Topcon TRC-NW8: 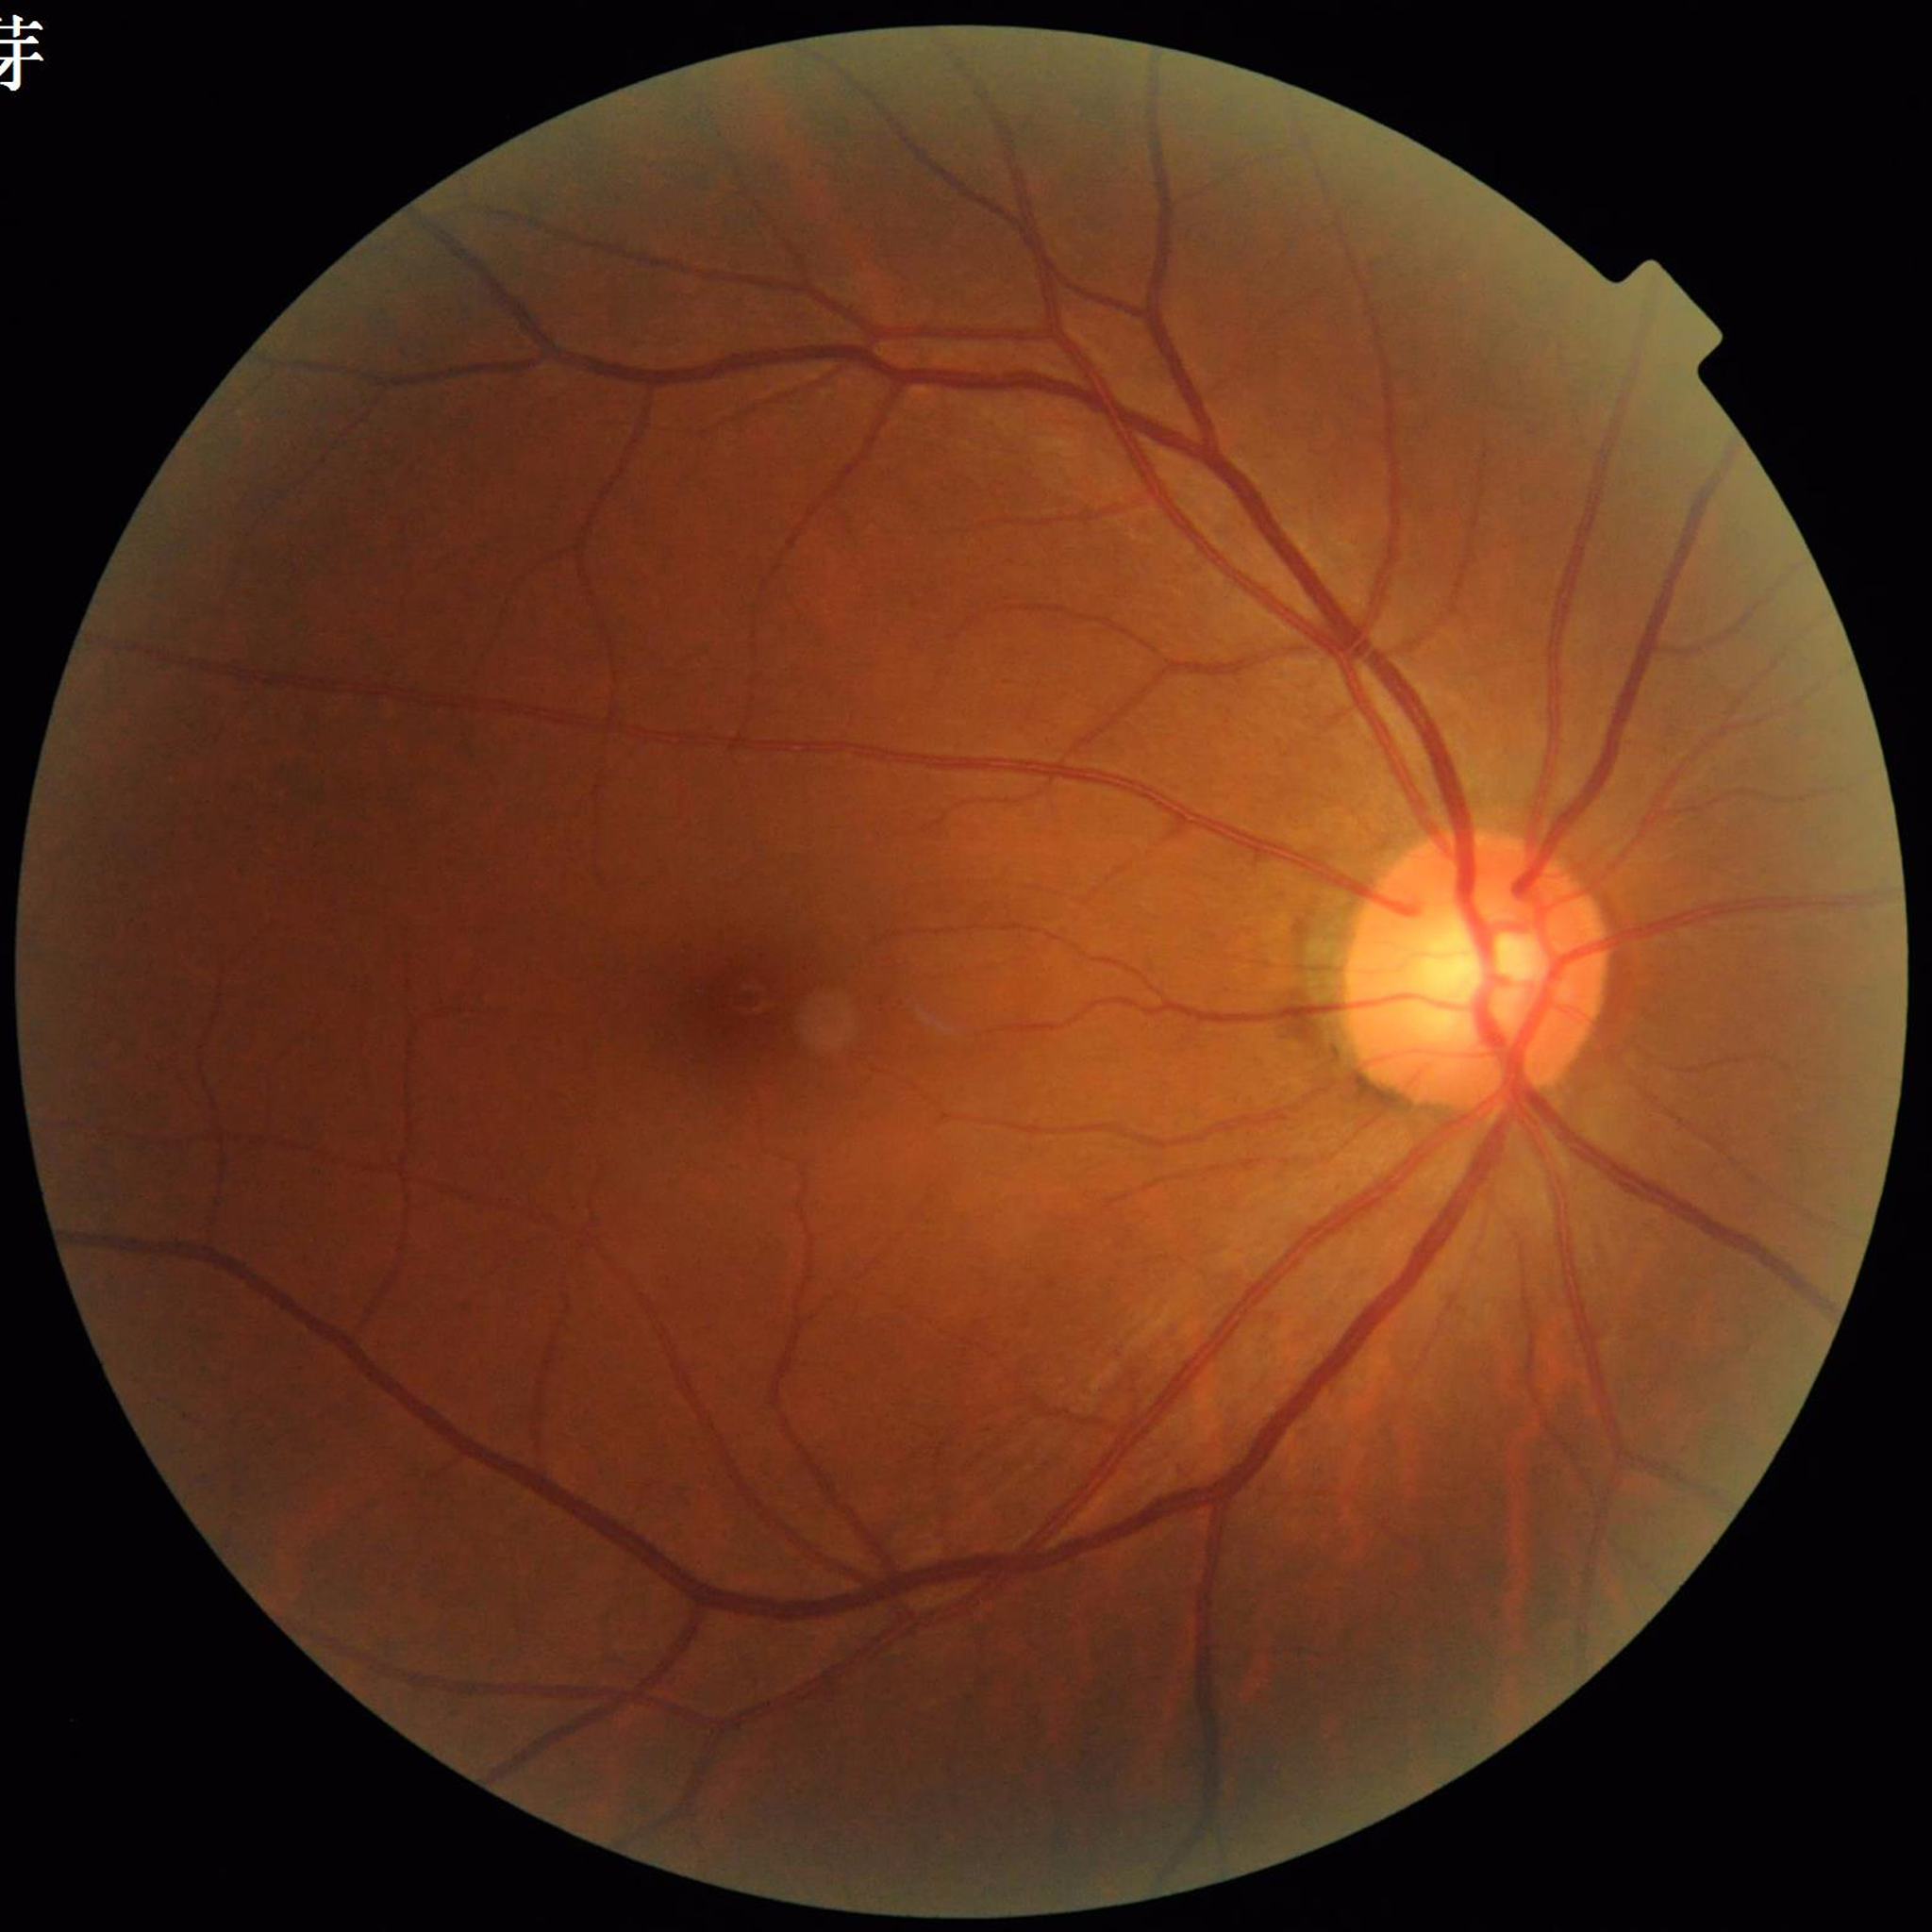 {"diagnosis": "DR"}